45° FOV.
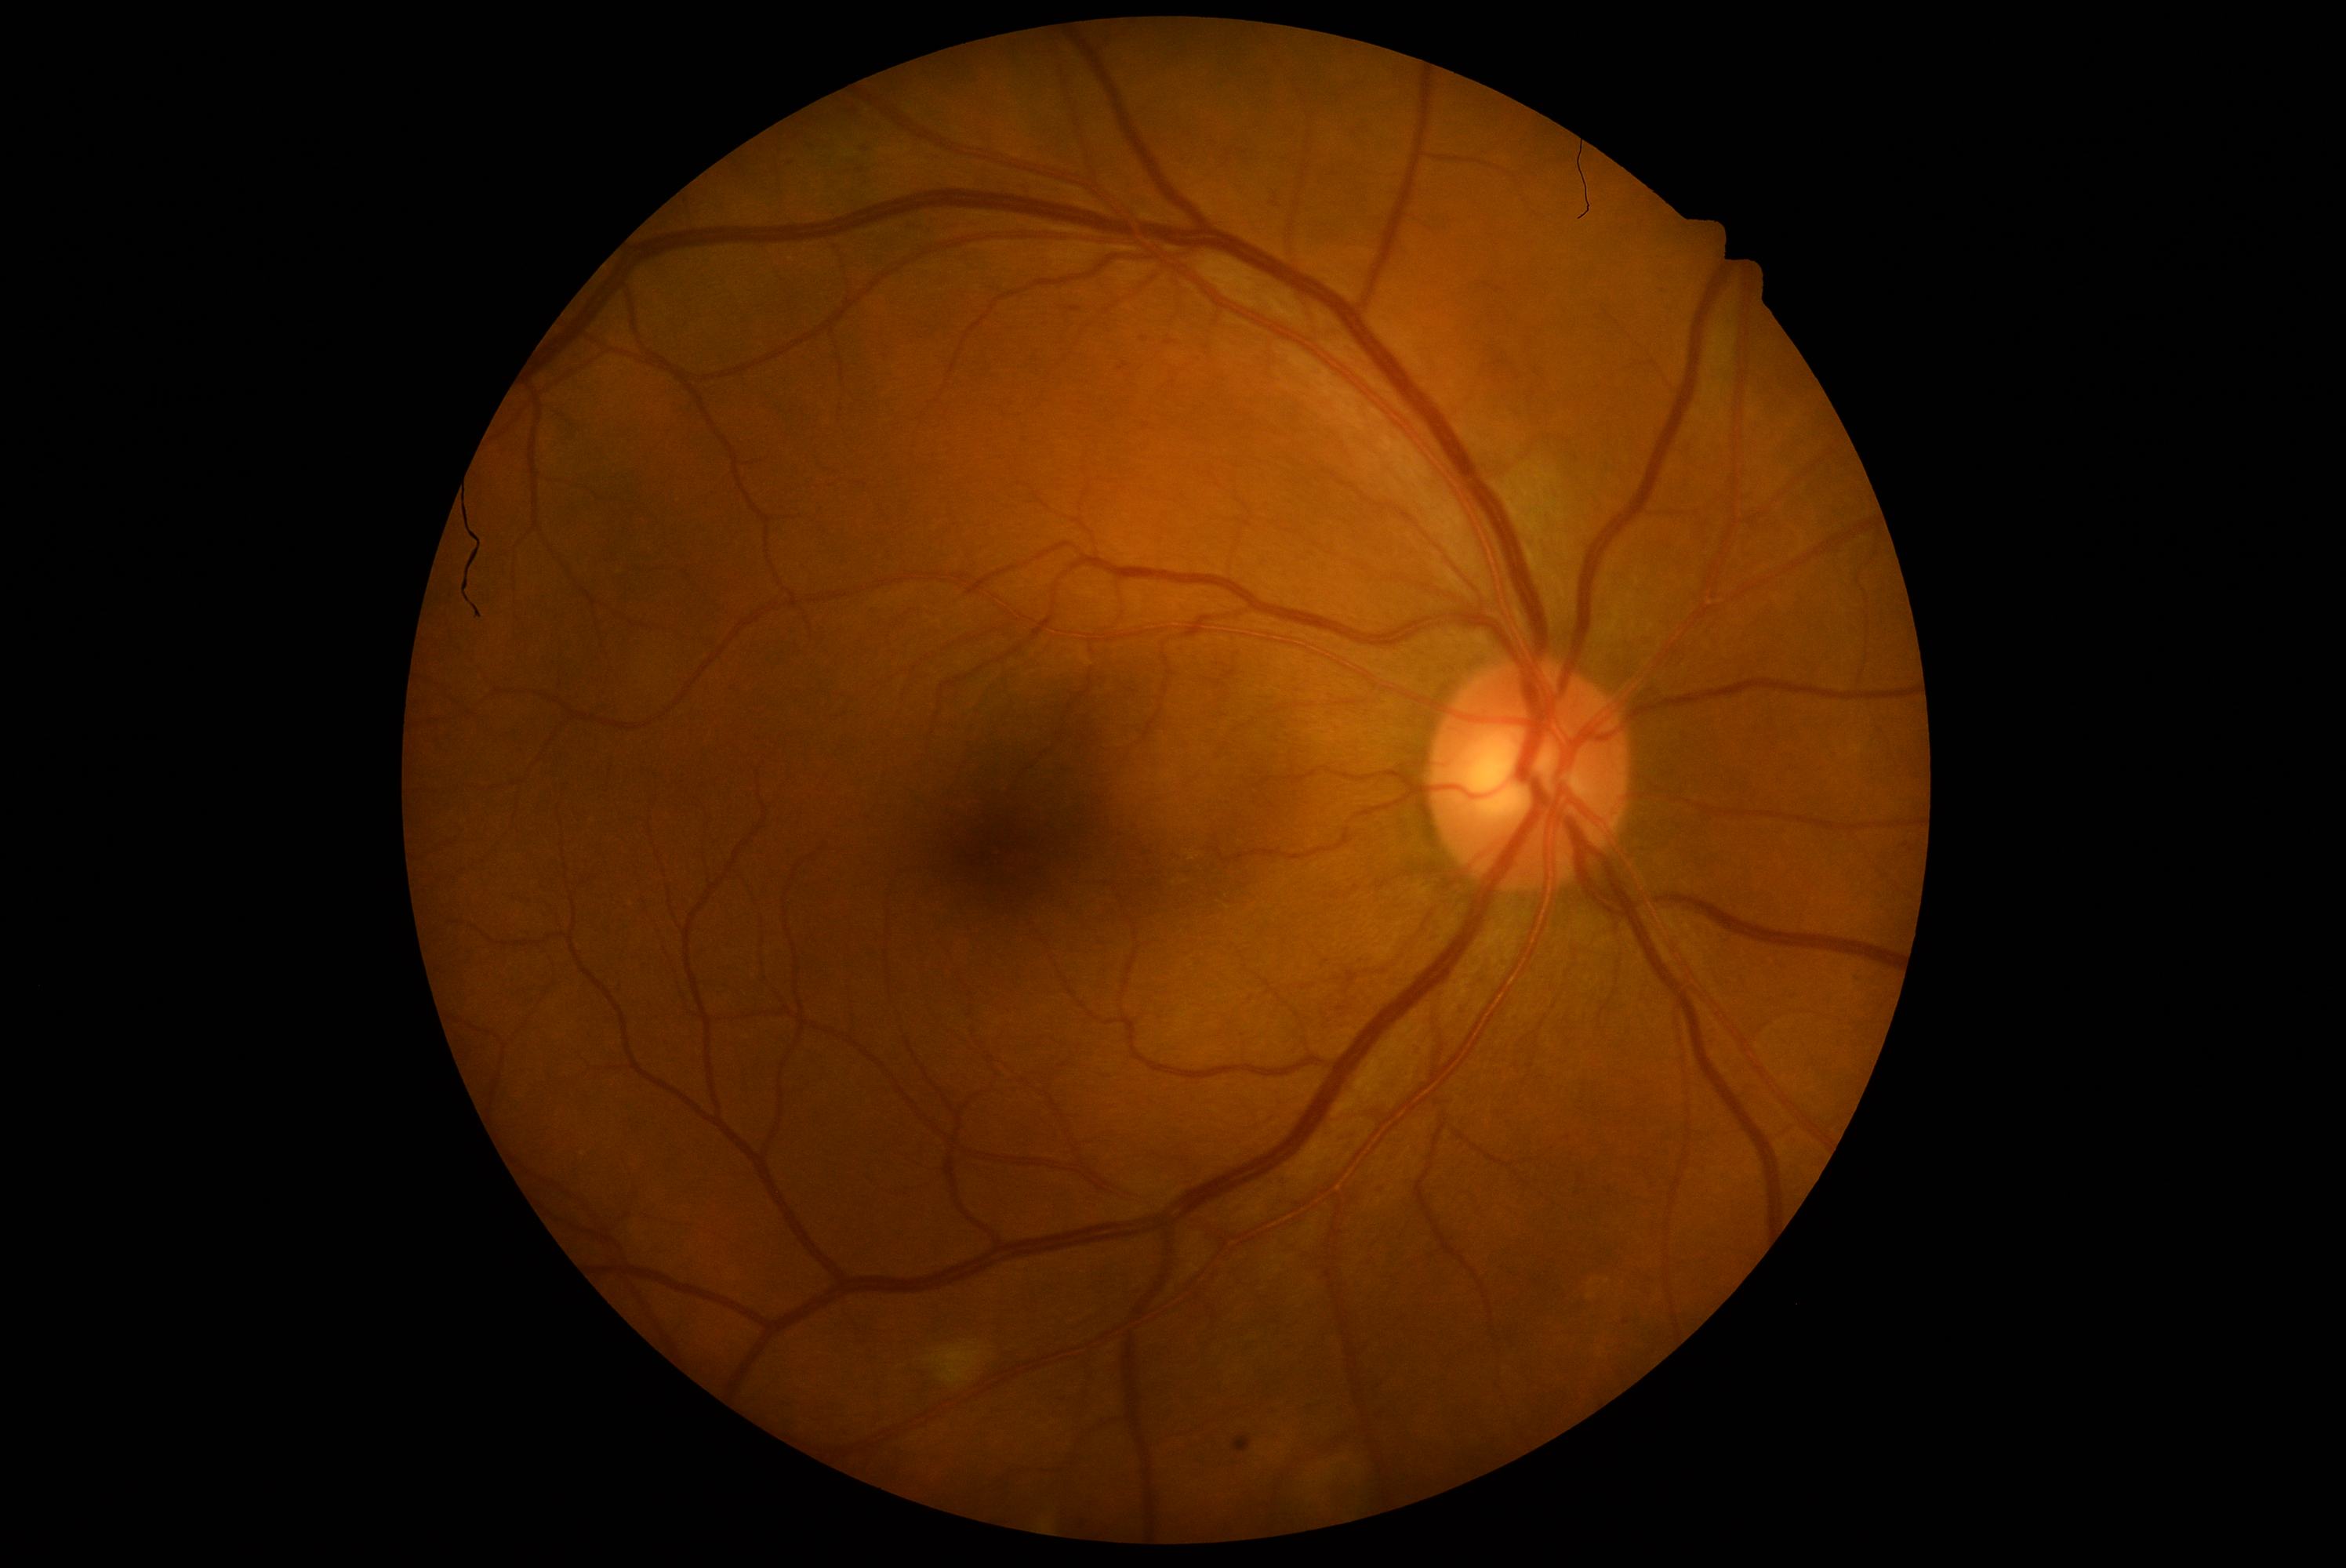

Diabetic retinopathy grade is 2; non-proliferative diabetic retinopathy
hard exudates: not present
soft exudates: 931 1345 981 1384; 965 1341 978 1346
hemorrhages: not present
microaneurysms: 1273 200 1280 208; 1141 336 1149 343; 1117 363 1128 372; 1067 307 1081 313; 1232 1436 1252 1453
Microaneurysms (small, approximate centers) near 791, 163; 866, 149